Image size 848x848:
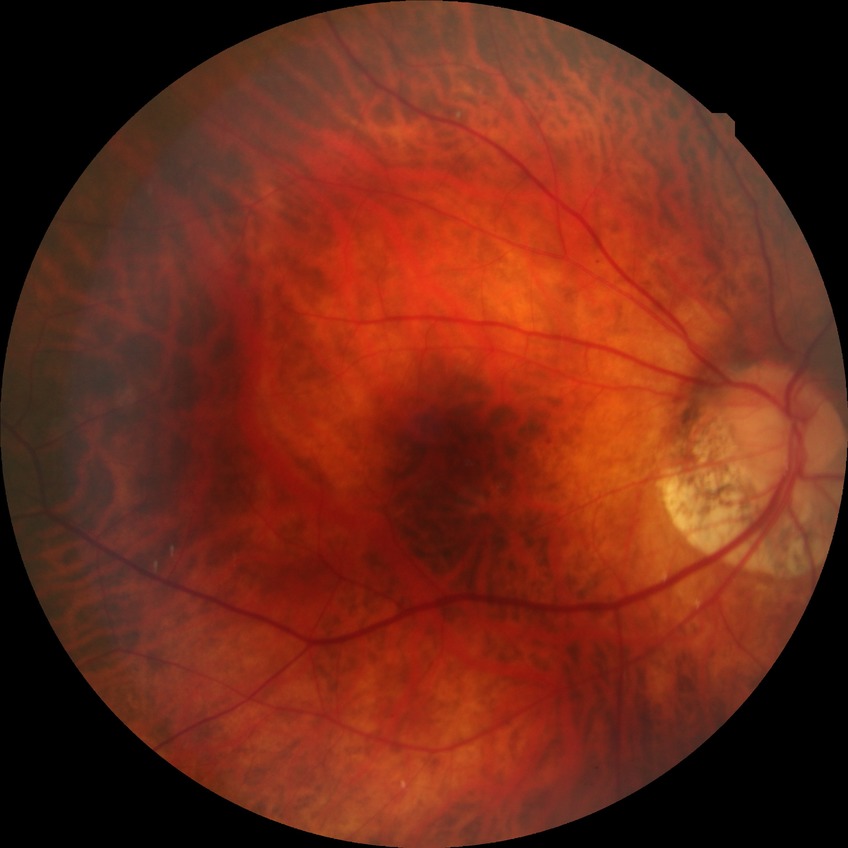
diabetic retinopathy (DR) = NDR (no diabetic retinopathy).